45° field of view.
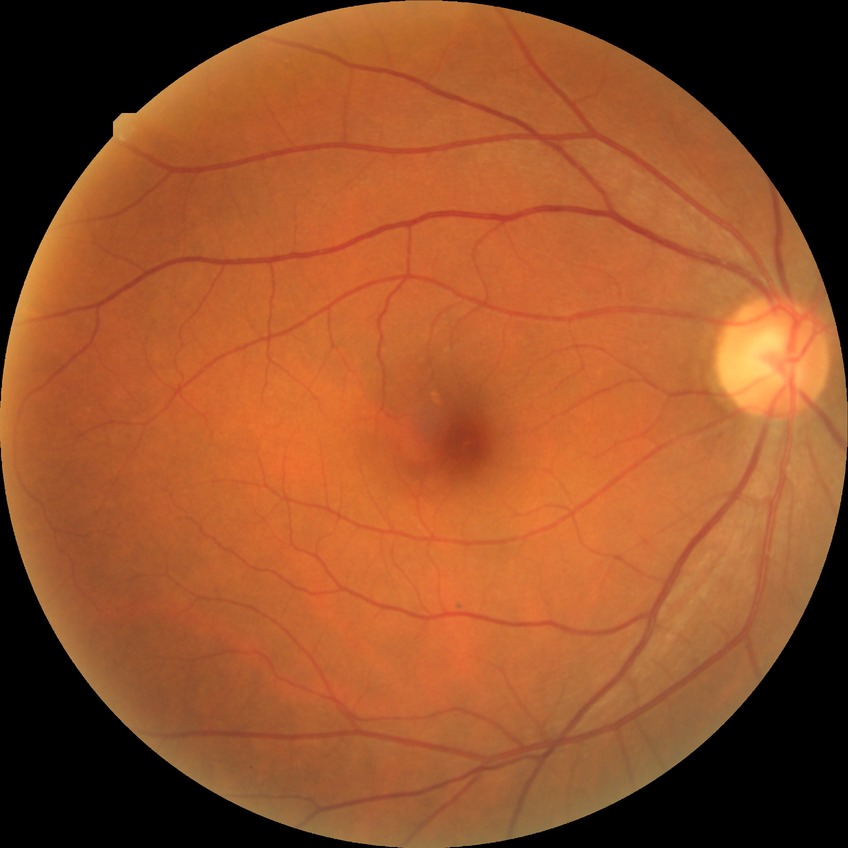 Davis DR grade is SDR.